1240 x 1240 pixels · wide-field fundus image from infant ROP screening:
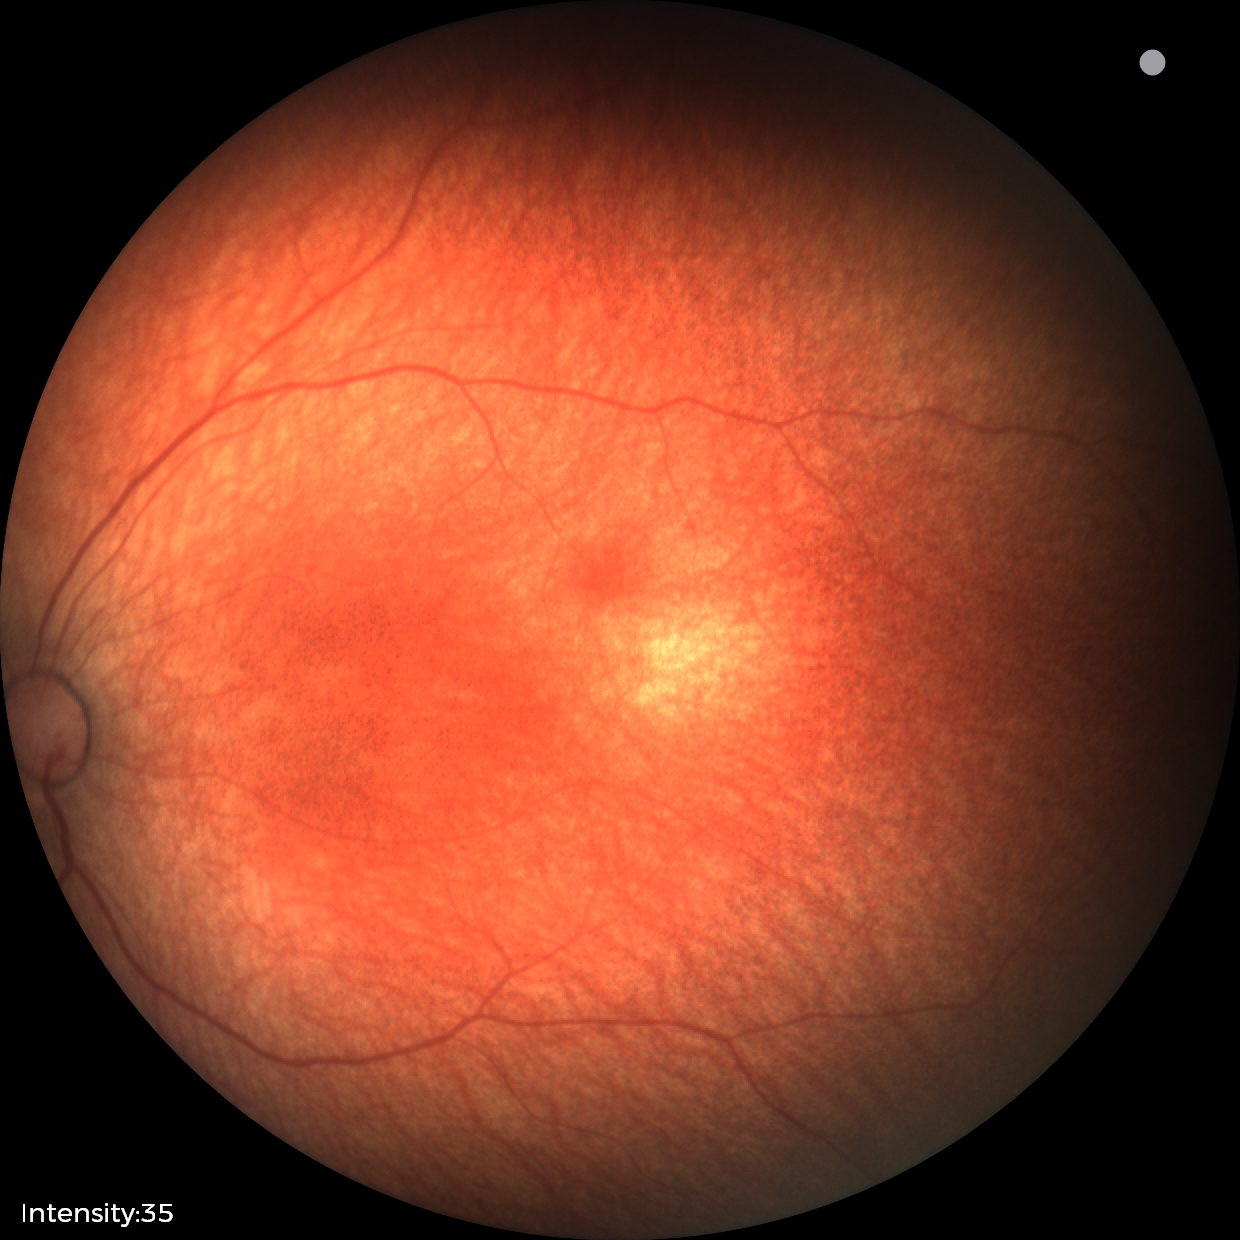

Impression = no abnormalities.